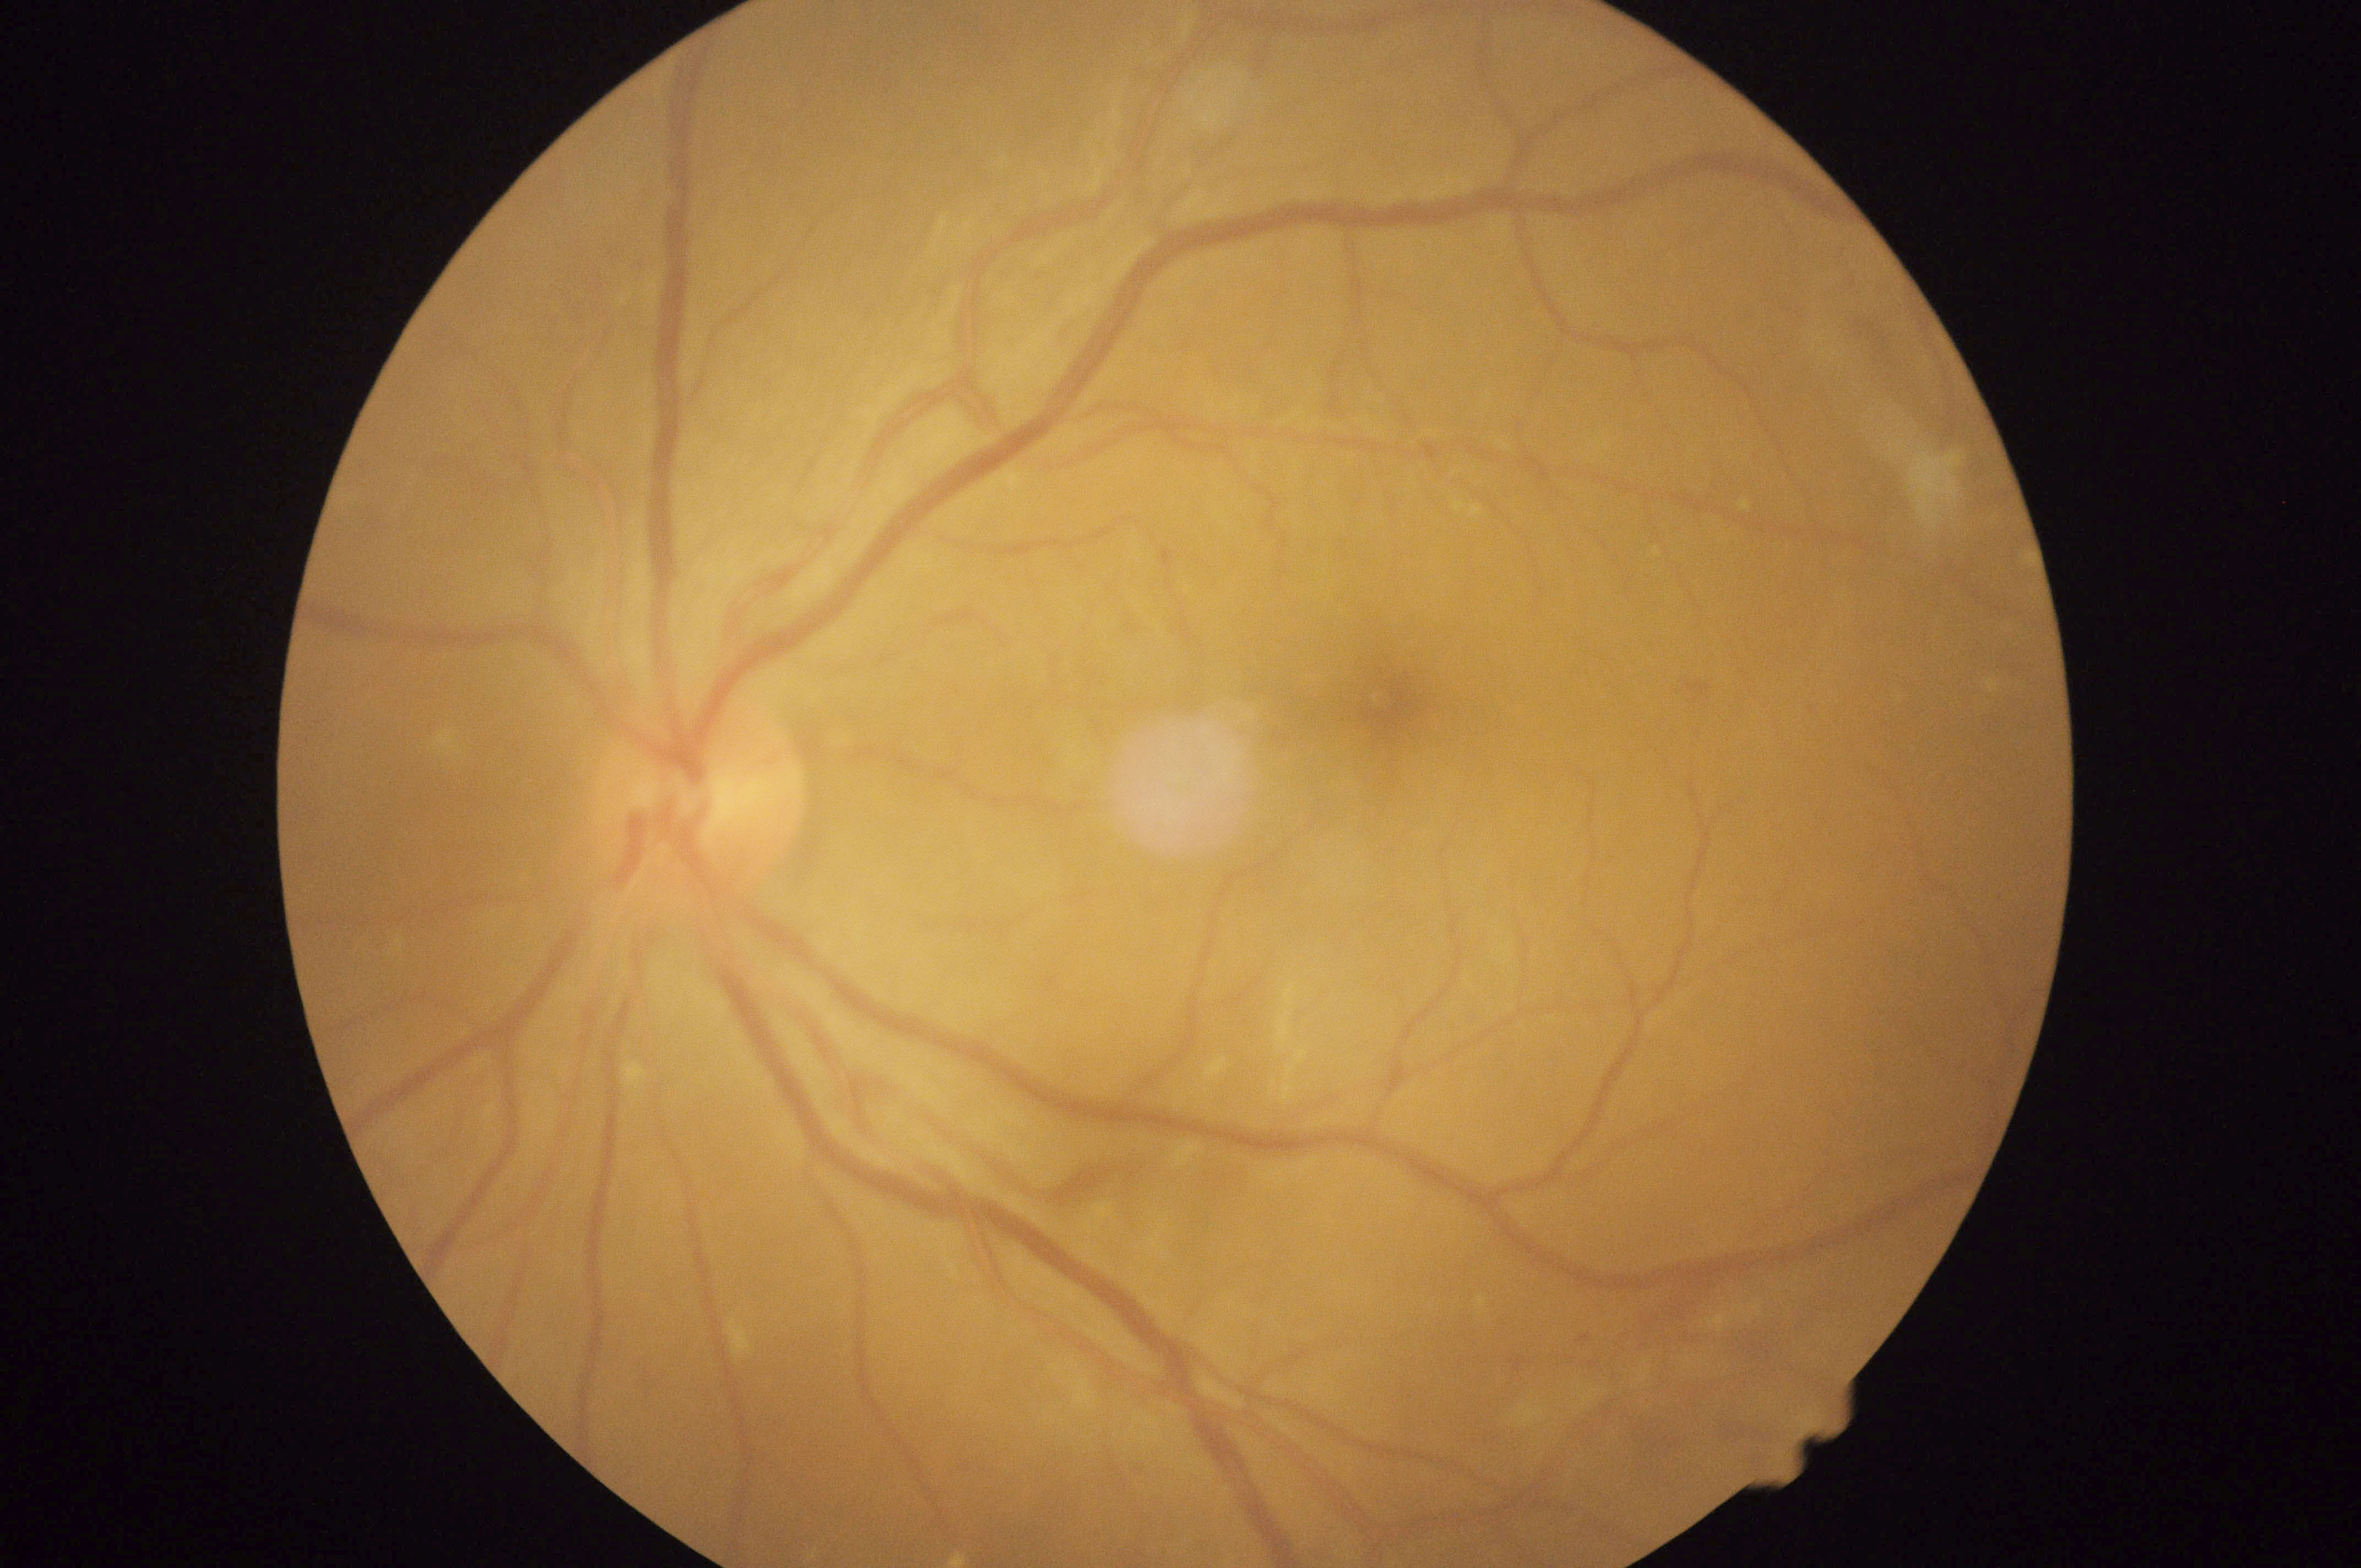

Diabetic retinopathy (DR) is moderate NPDR (grade 2).